45 degree fundus photograph:
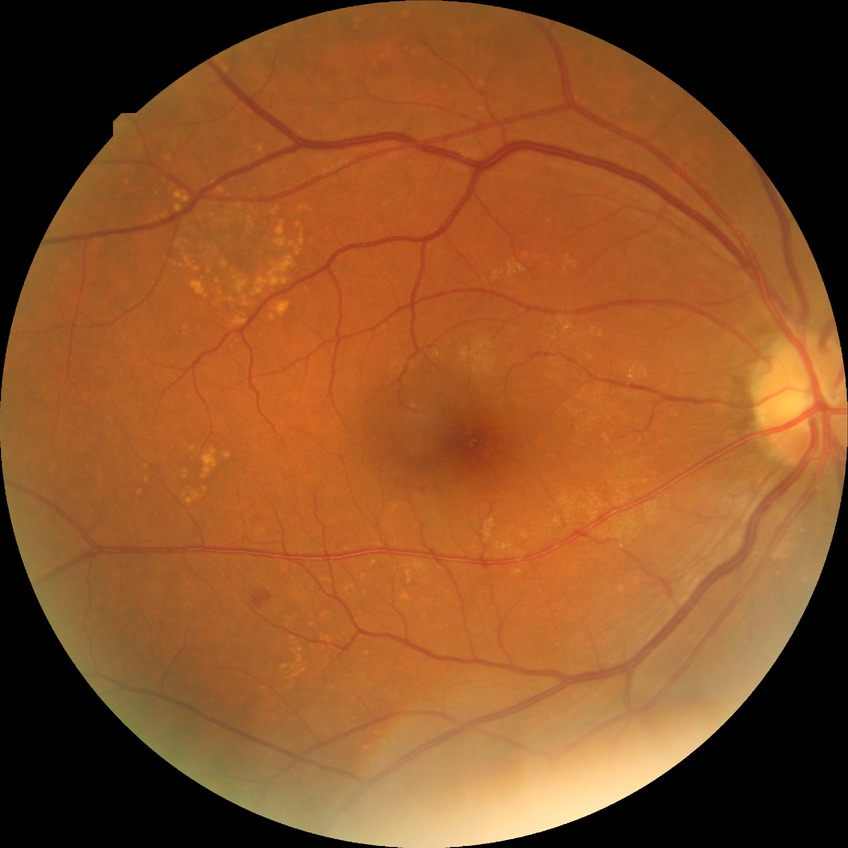

The retinopathy is classified as non-proliferative diabetic retinopathy. Diabetic retinopathy grade is simple diabetic retinopathy.